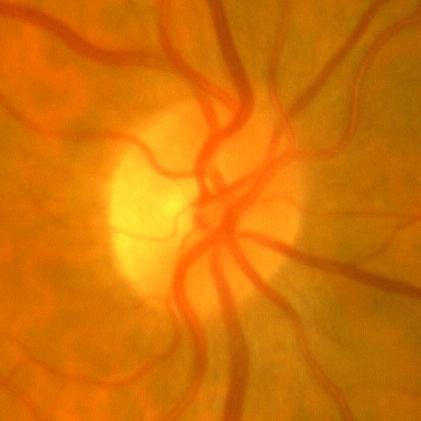
ONH-centered fundus image showing no glaucomatous optic neuropathy.